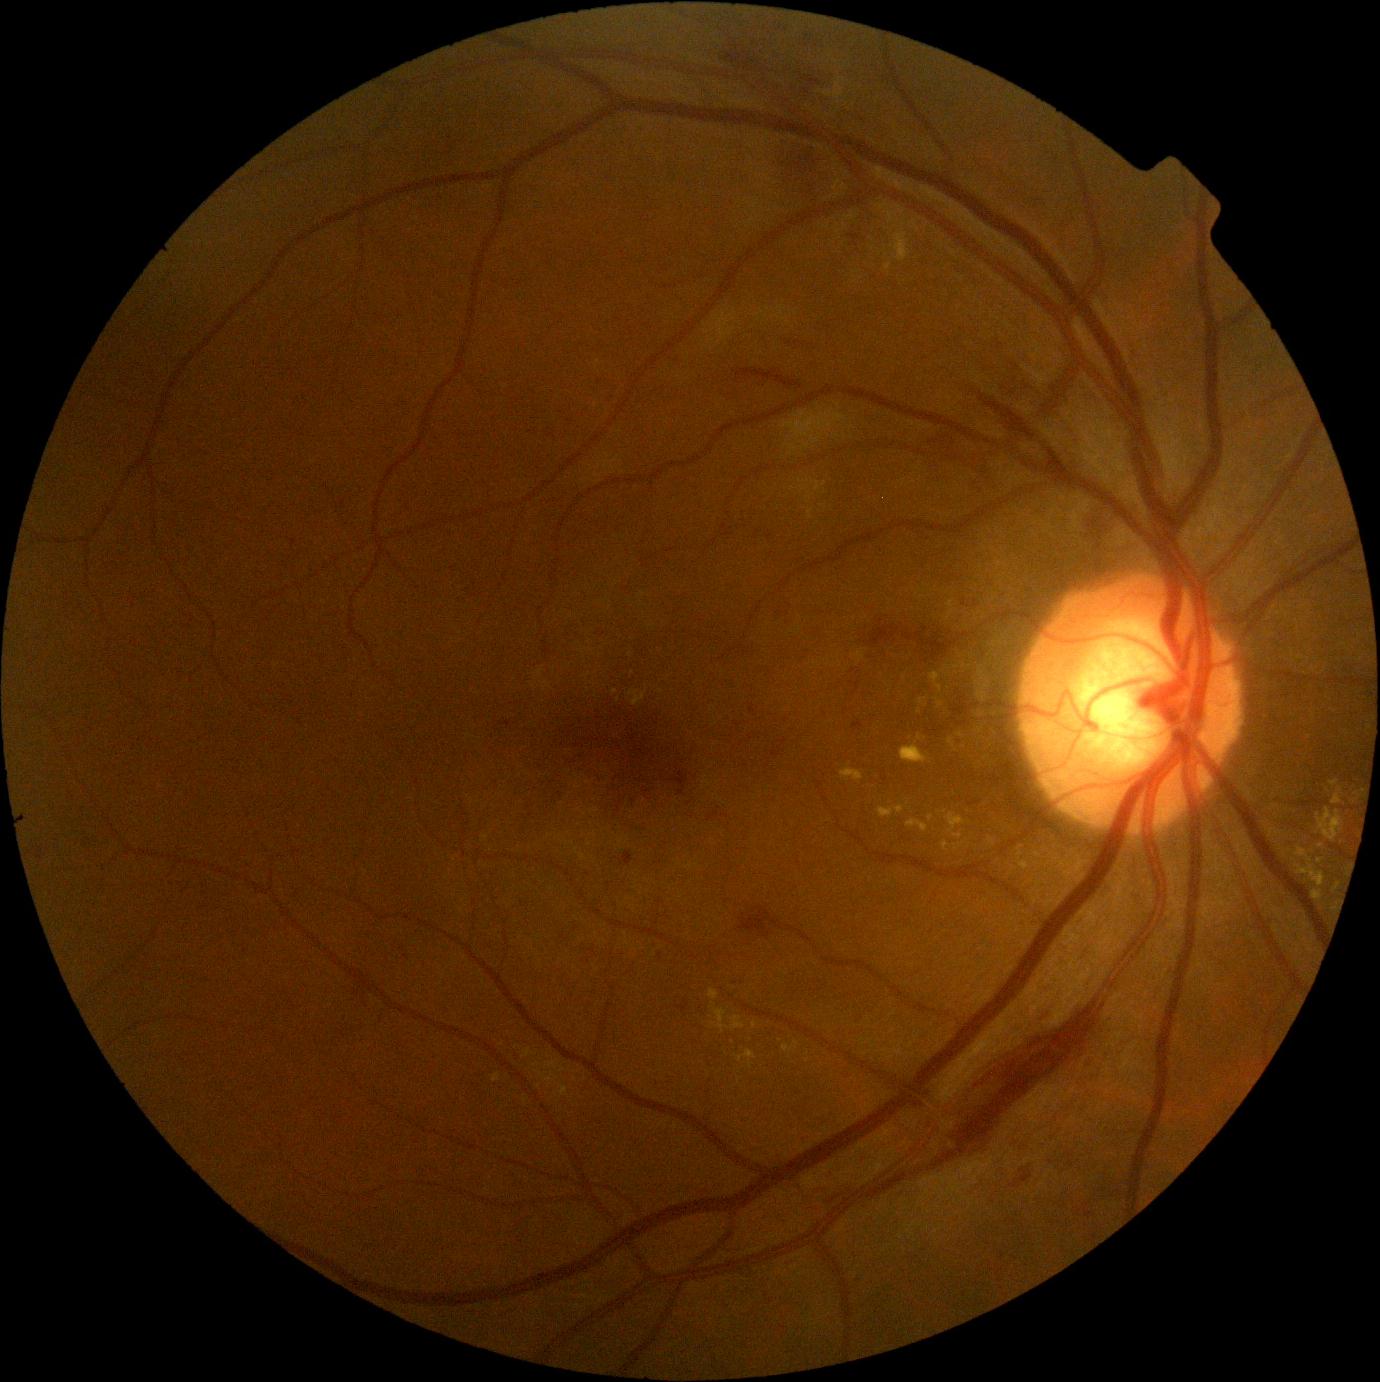 Diabetic retinopathy (DR): grade 2 (moderate NPDR).